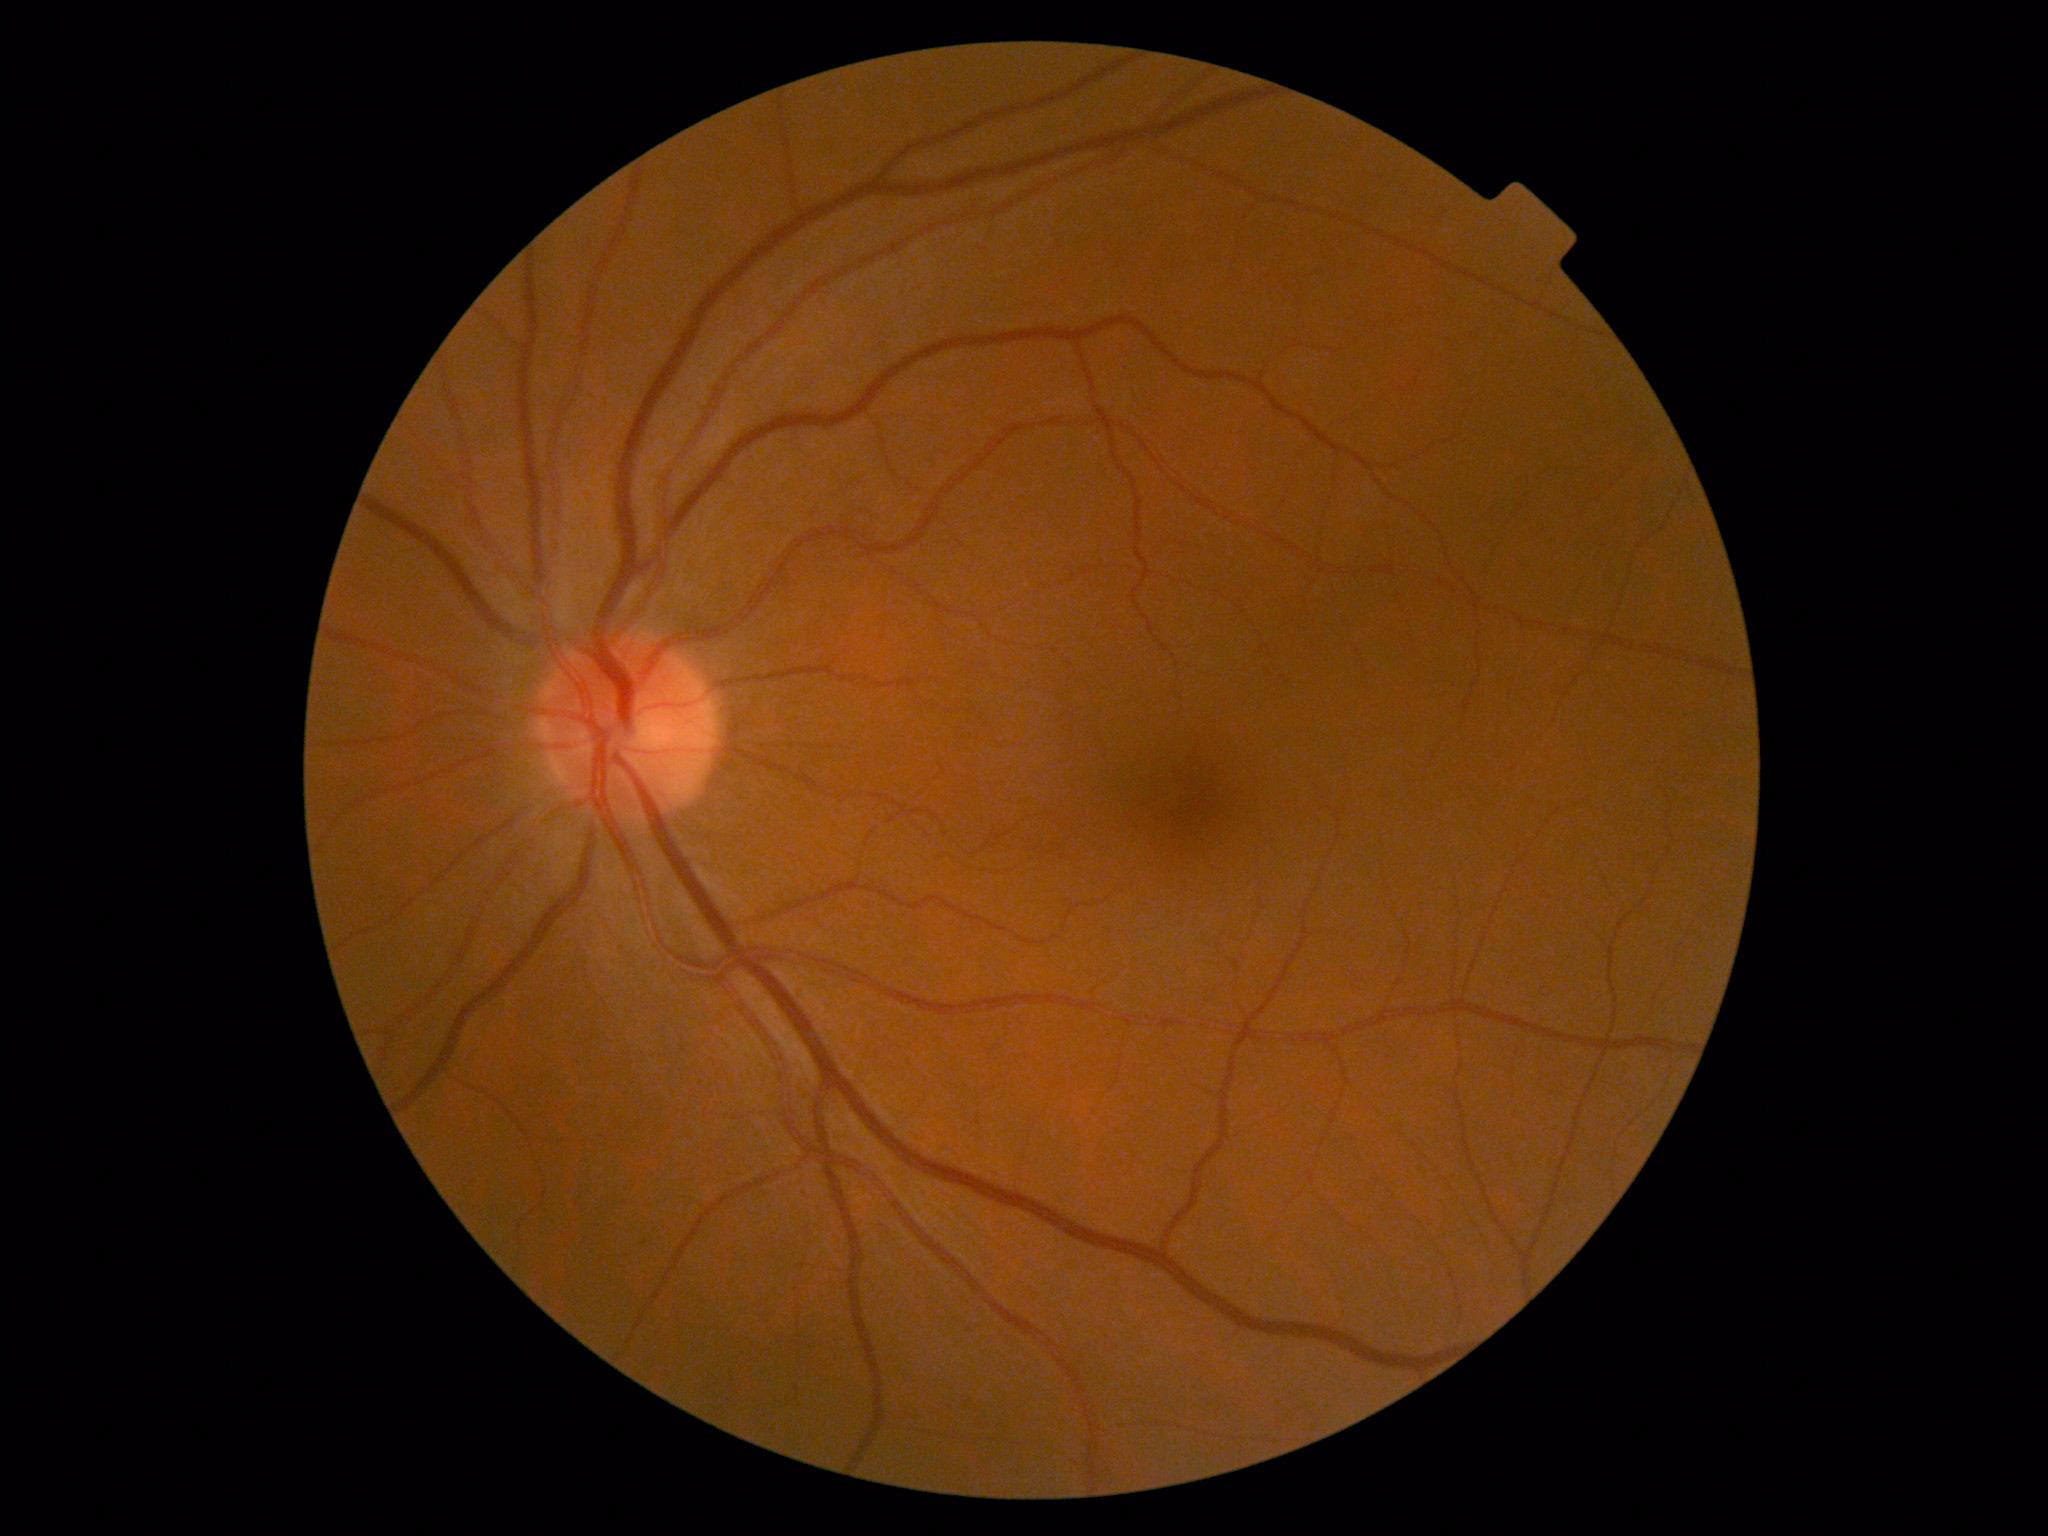

DR severity: grade 0 (no apparent retinopathy)